Color fundus image. Image size 1960x1897.
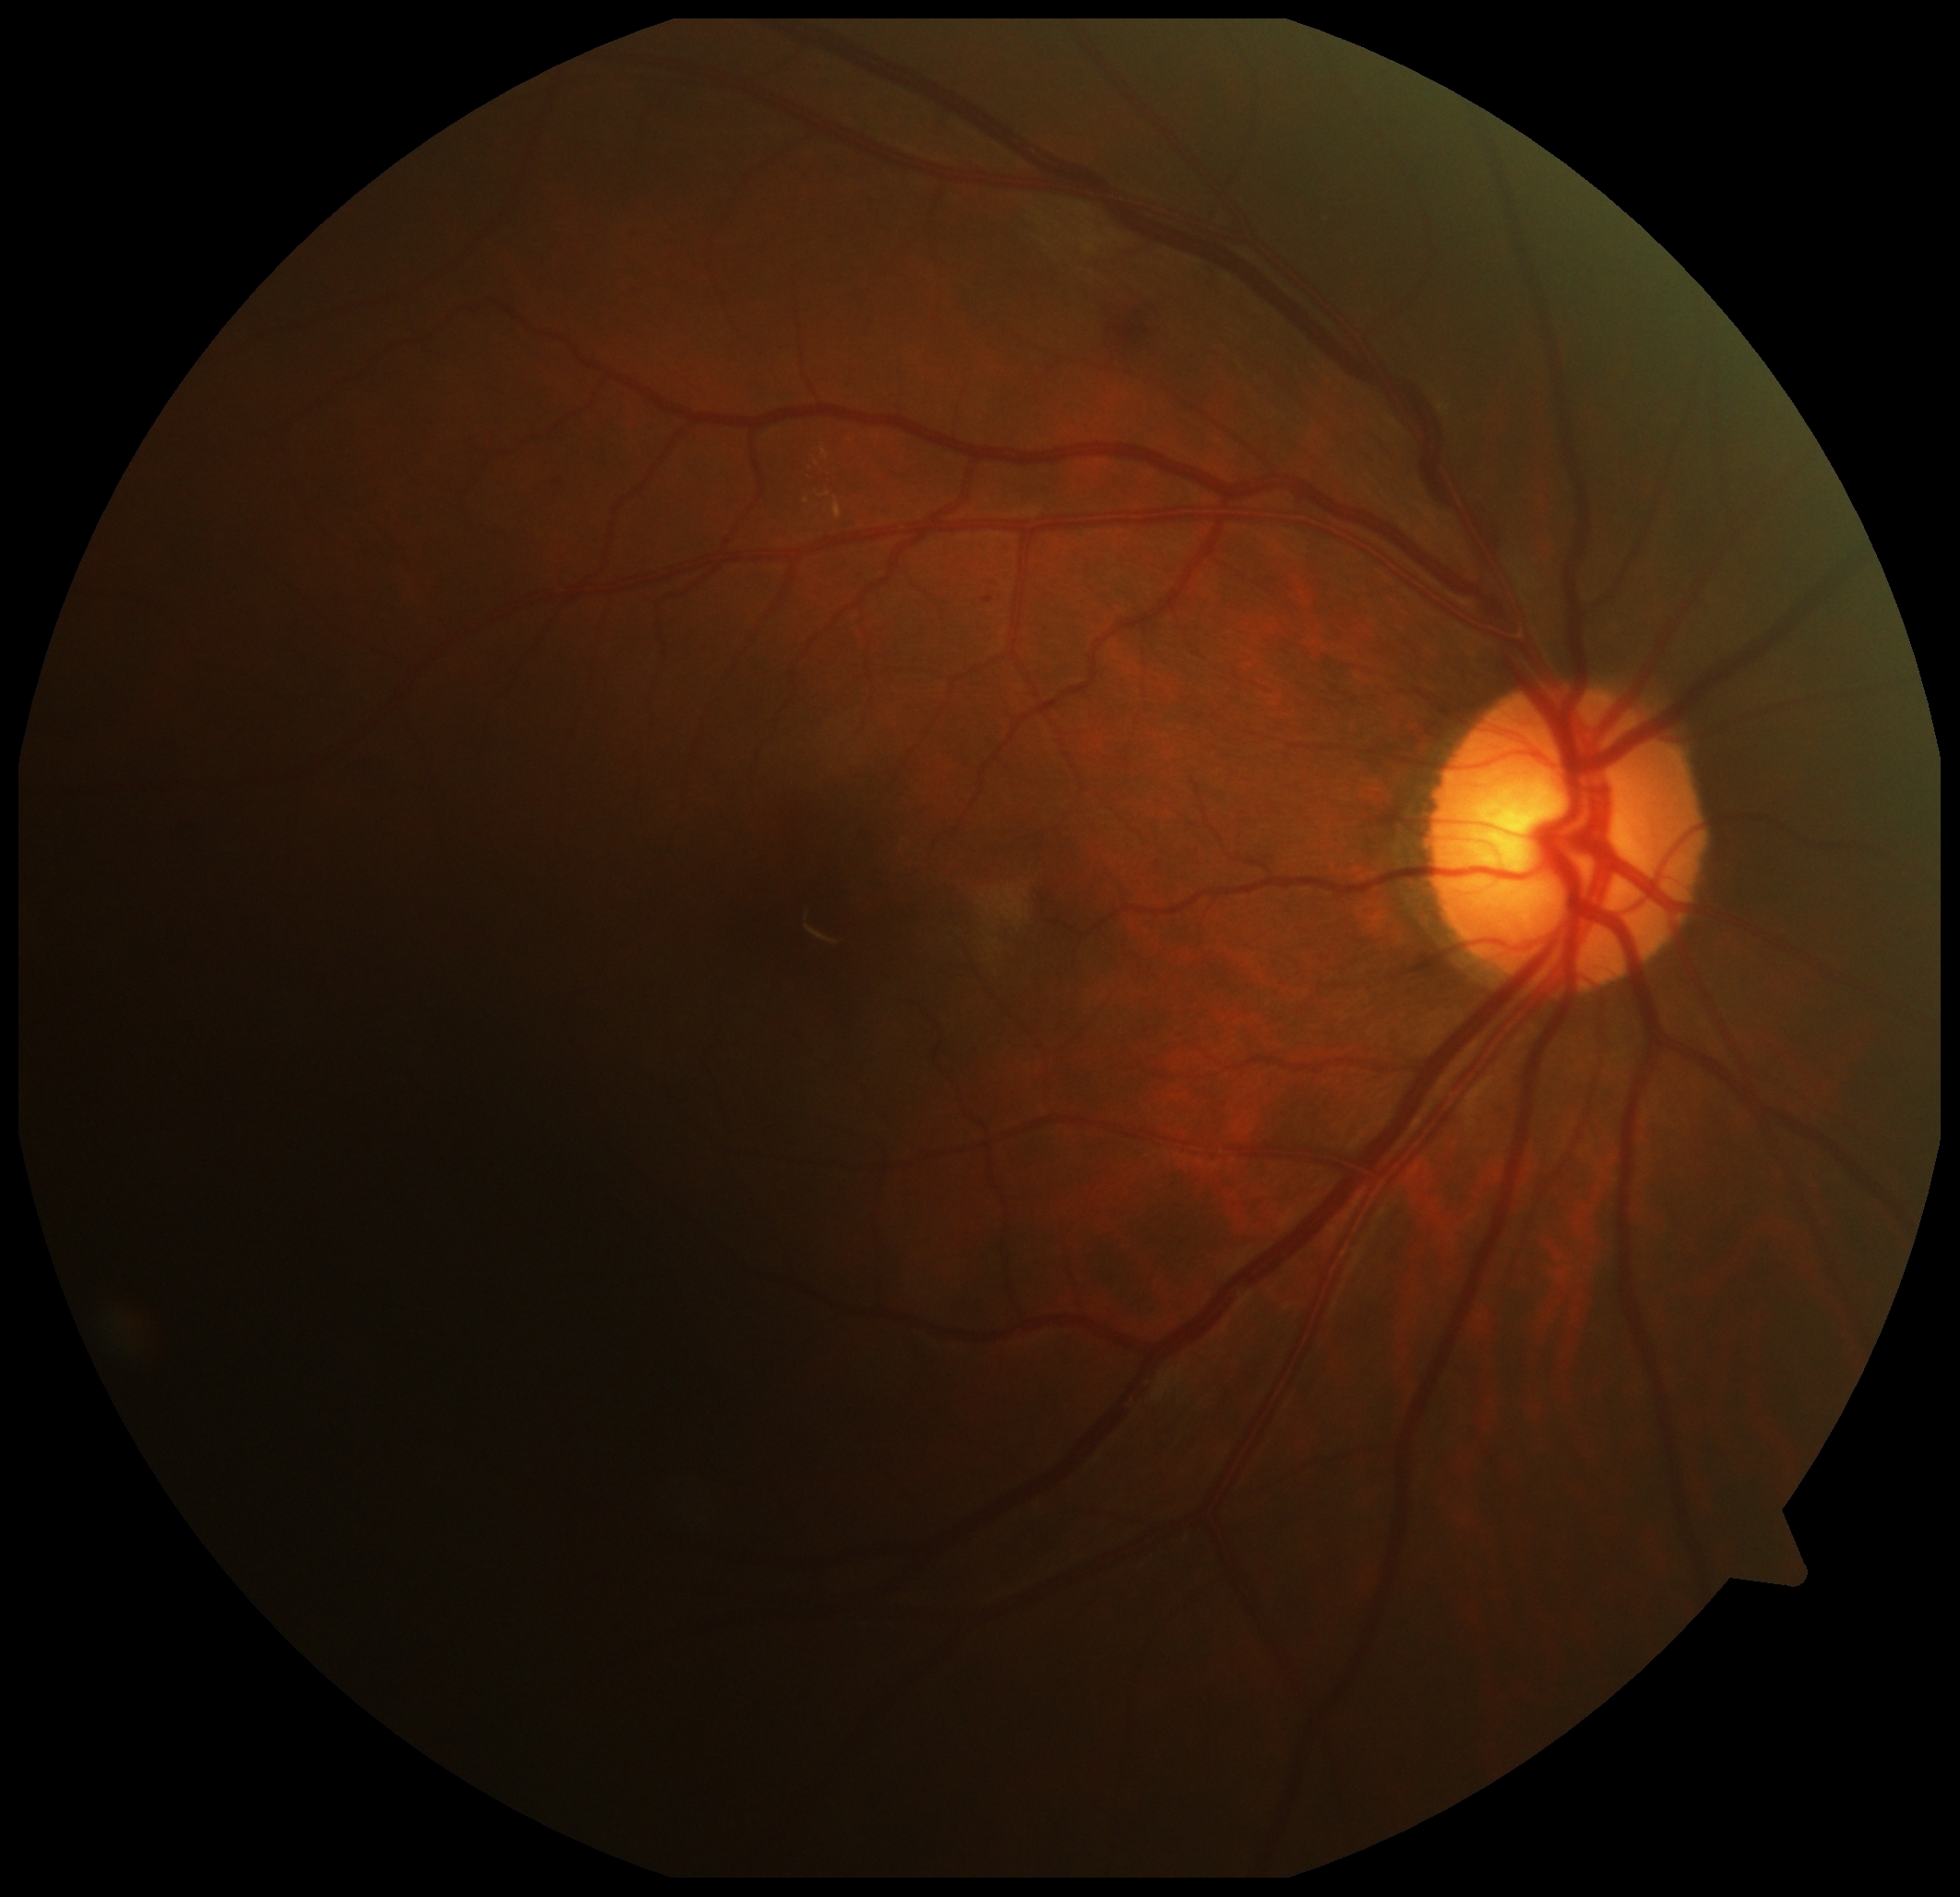

DR stage is 2.